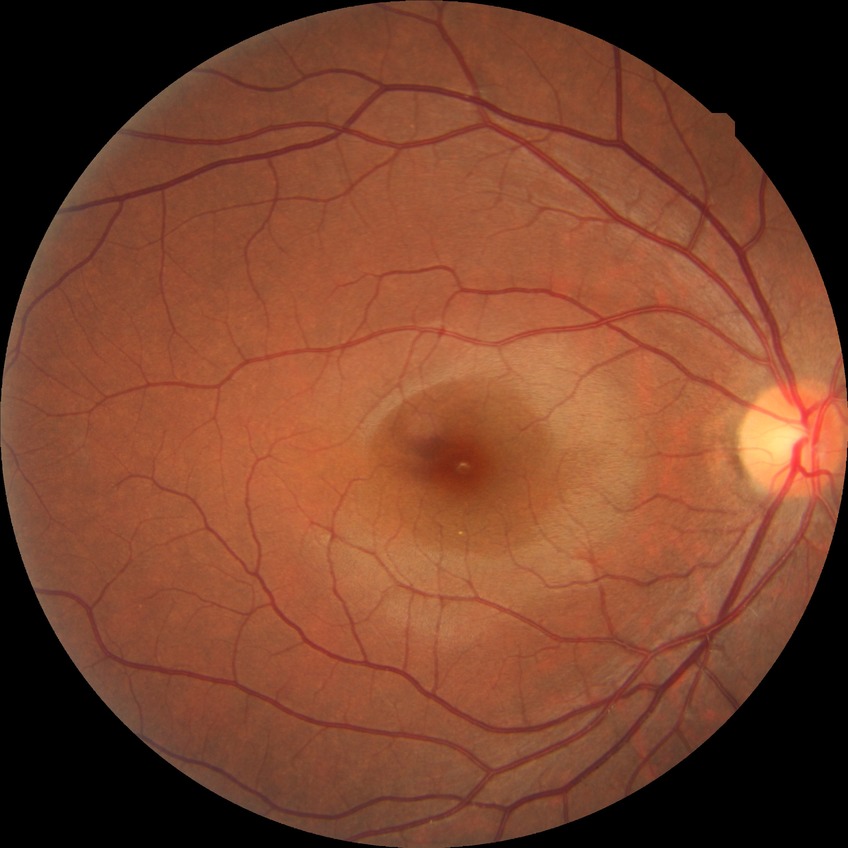
{
  "davis_grade": "NDR"
}